Retinal fundus photograph: 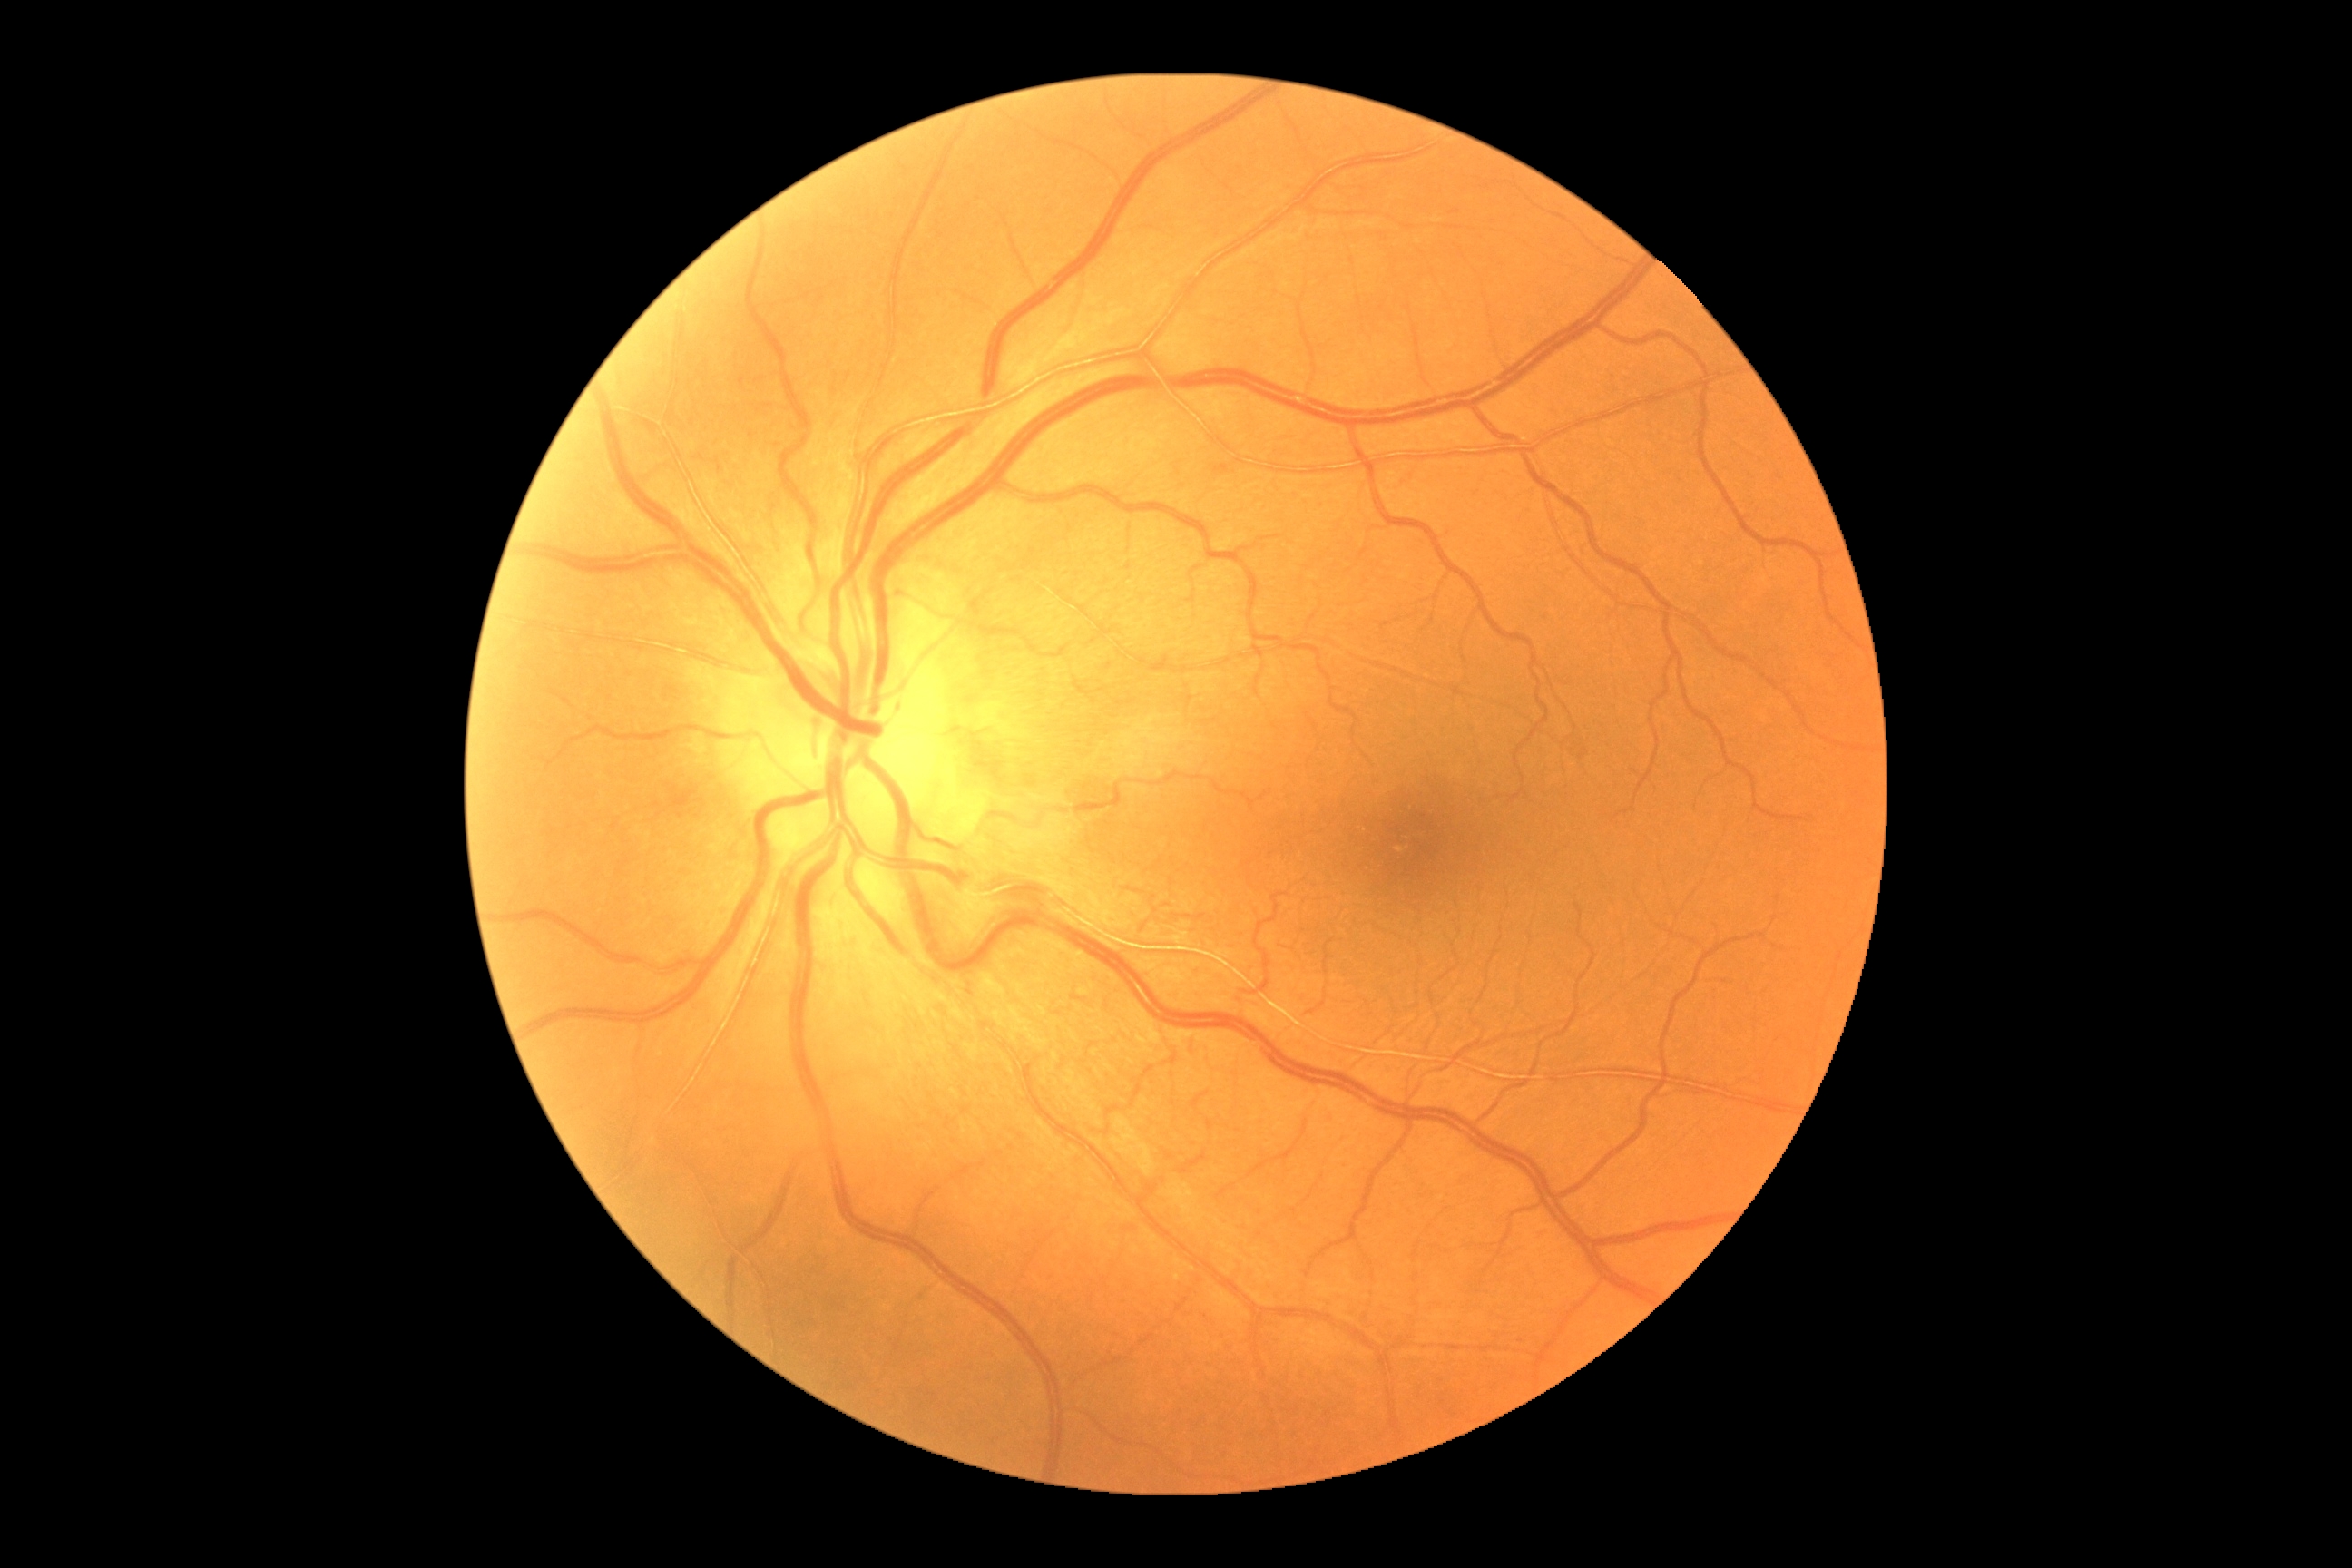
{
  "dr_impression": "no signs of DR",
  "dr_grade": "0/4 — no visible signs of diabetic retinopathy"
}